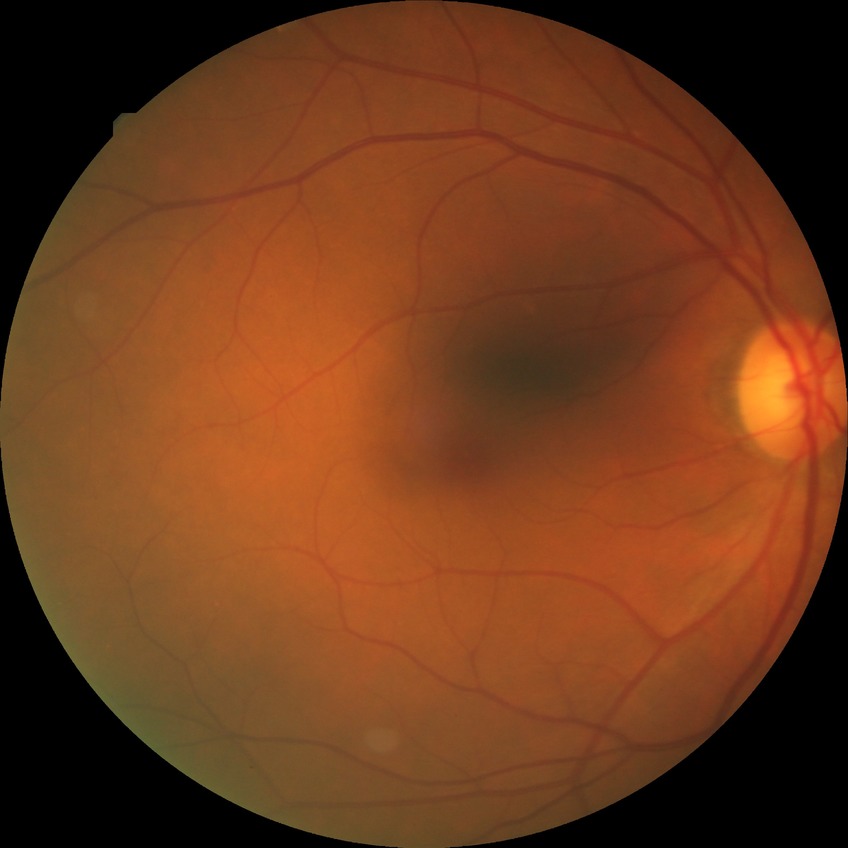

Diabetic retinopathy (DR): NDR (no diabetic retinopathy).